Wide-field fundus image from infant ROP screening. 1240 x 1240 pixels: 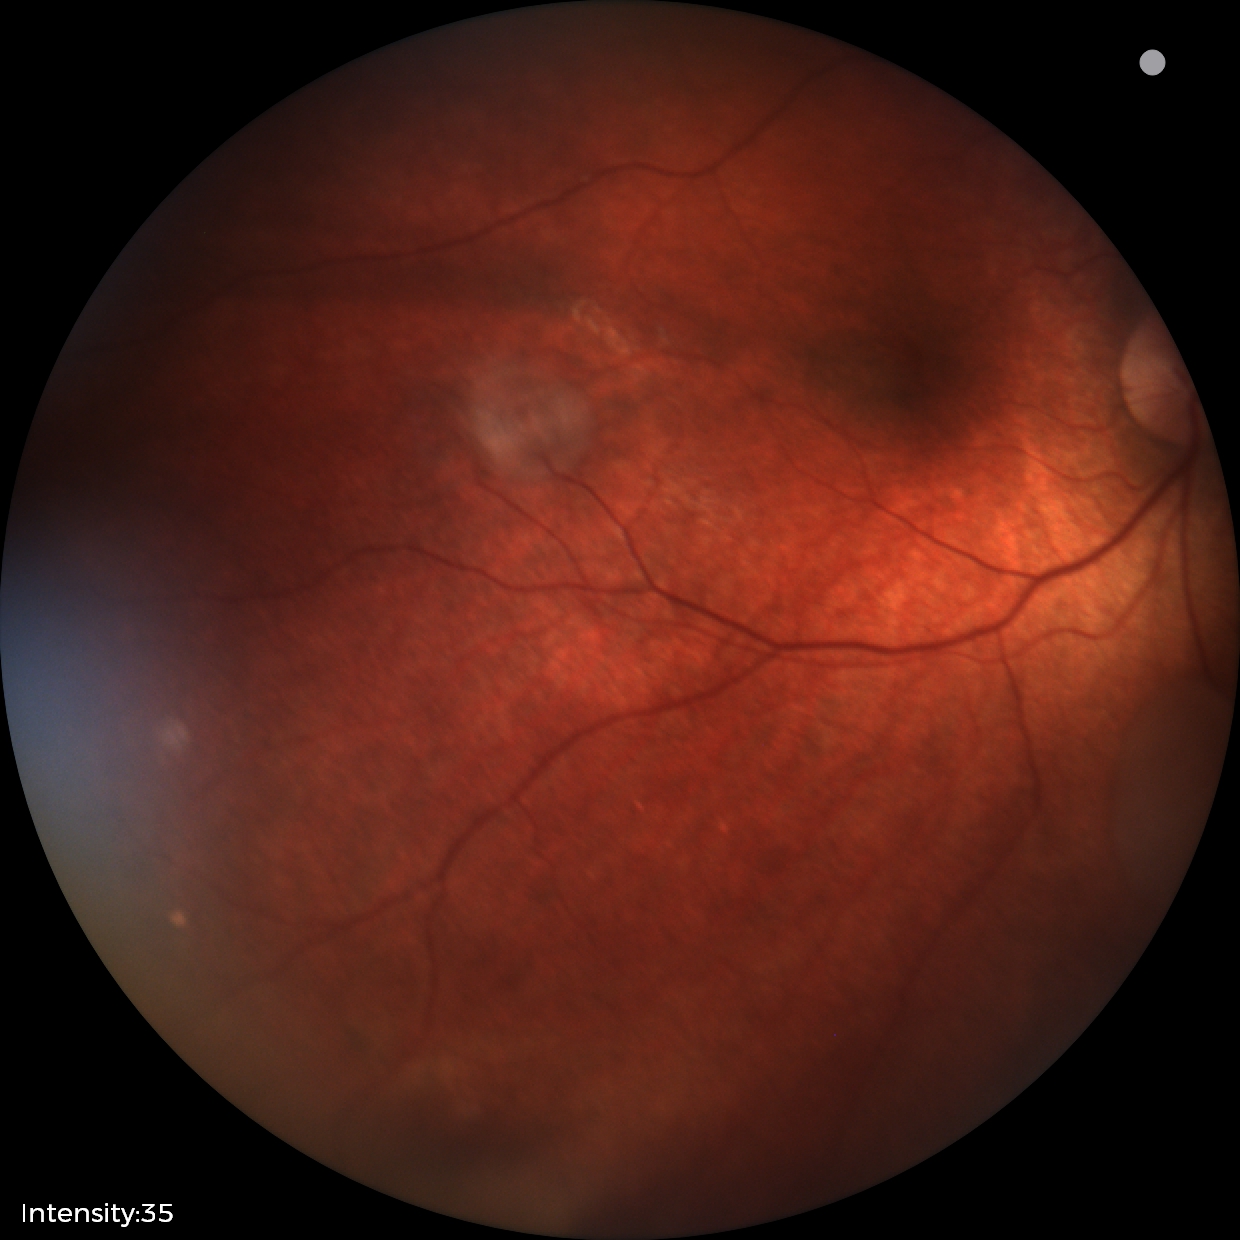

Screening series with retinal astrocytic hamartoma.